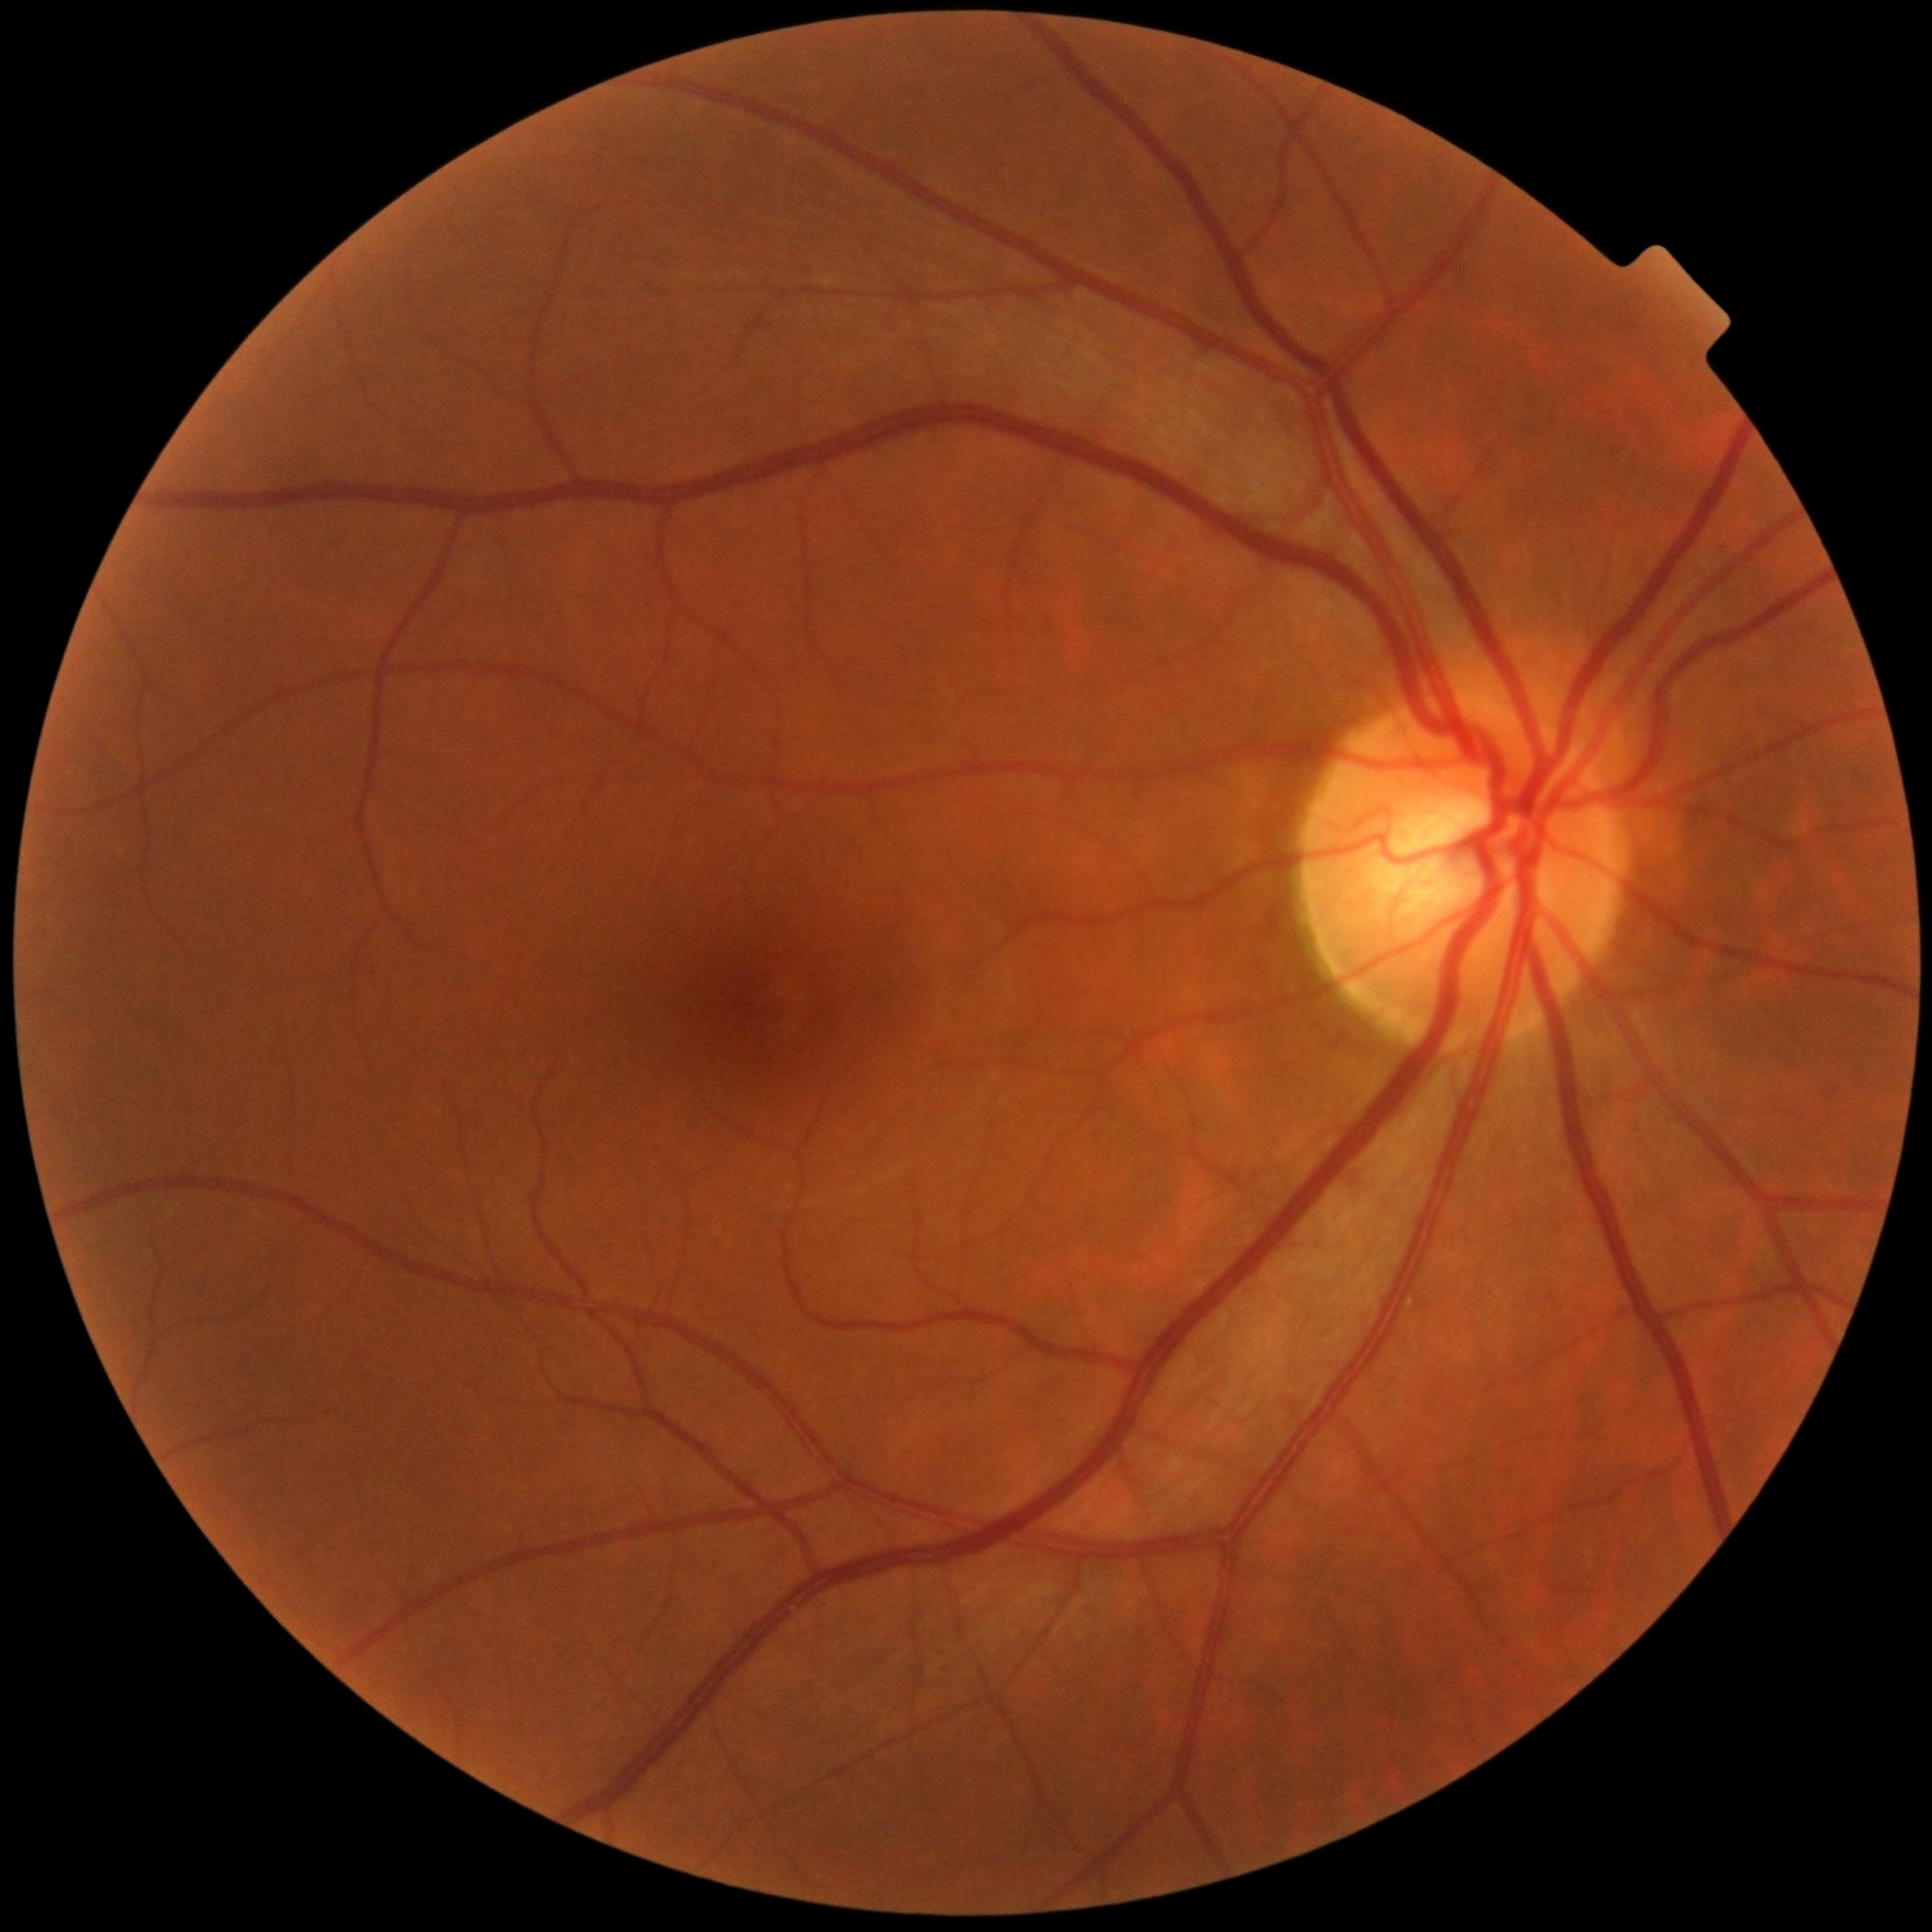
Annotations:
* diabetic retinopathy grade: 0 (no apparent retinopathy)